Captured on a Remidio Fundus on Phone · color fundus image:
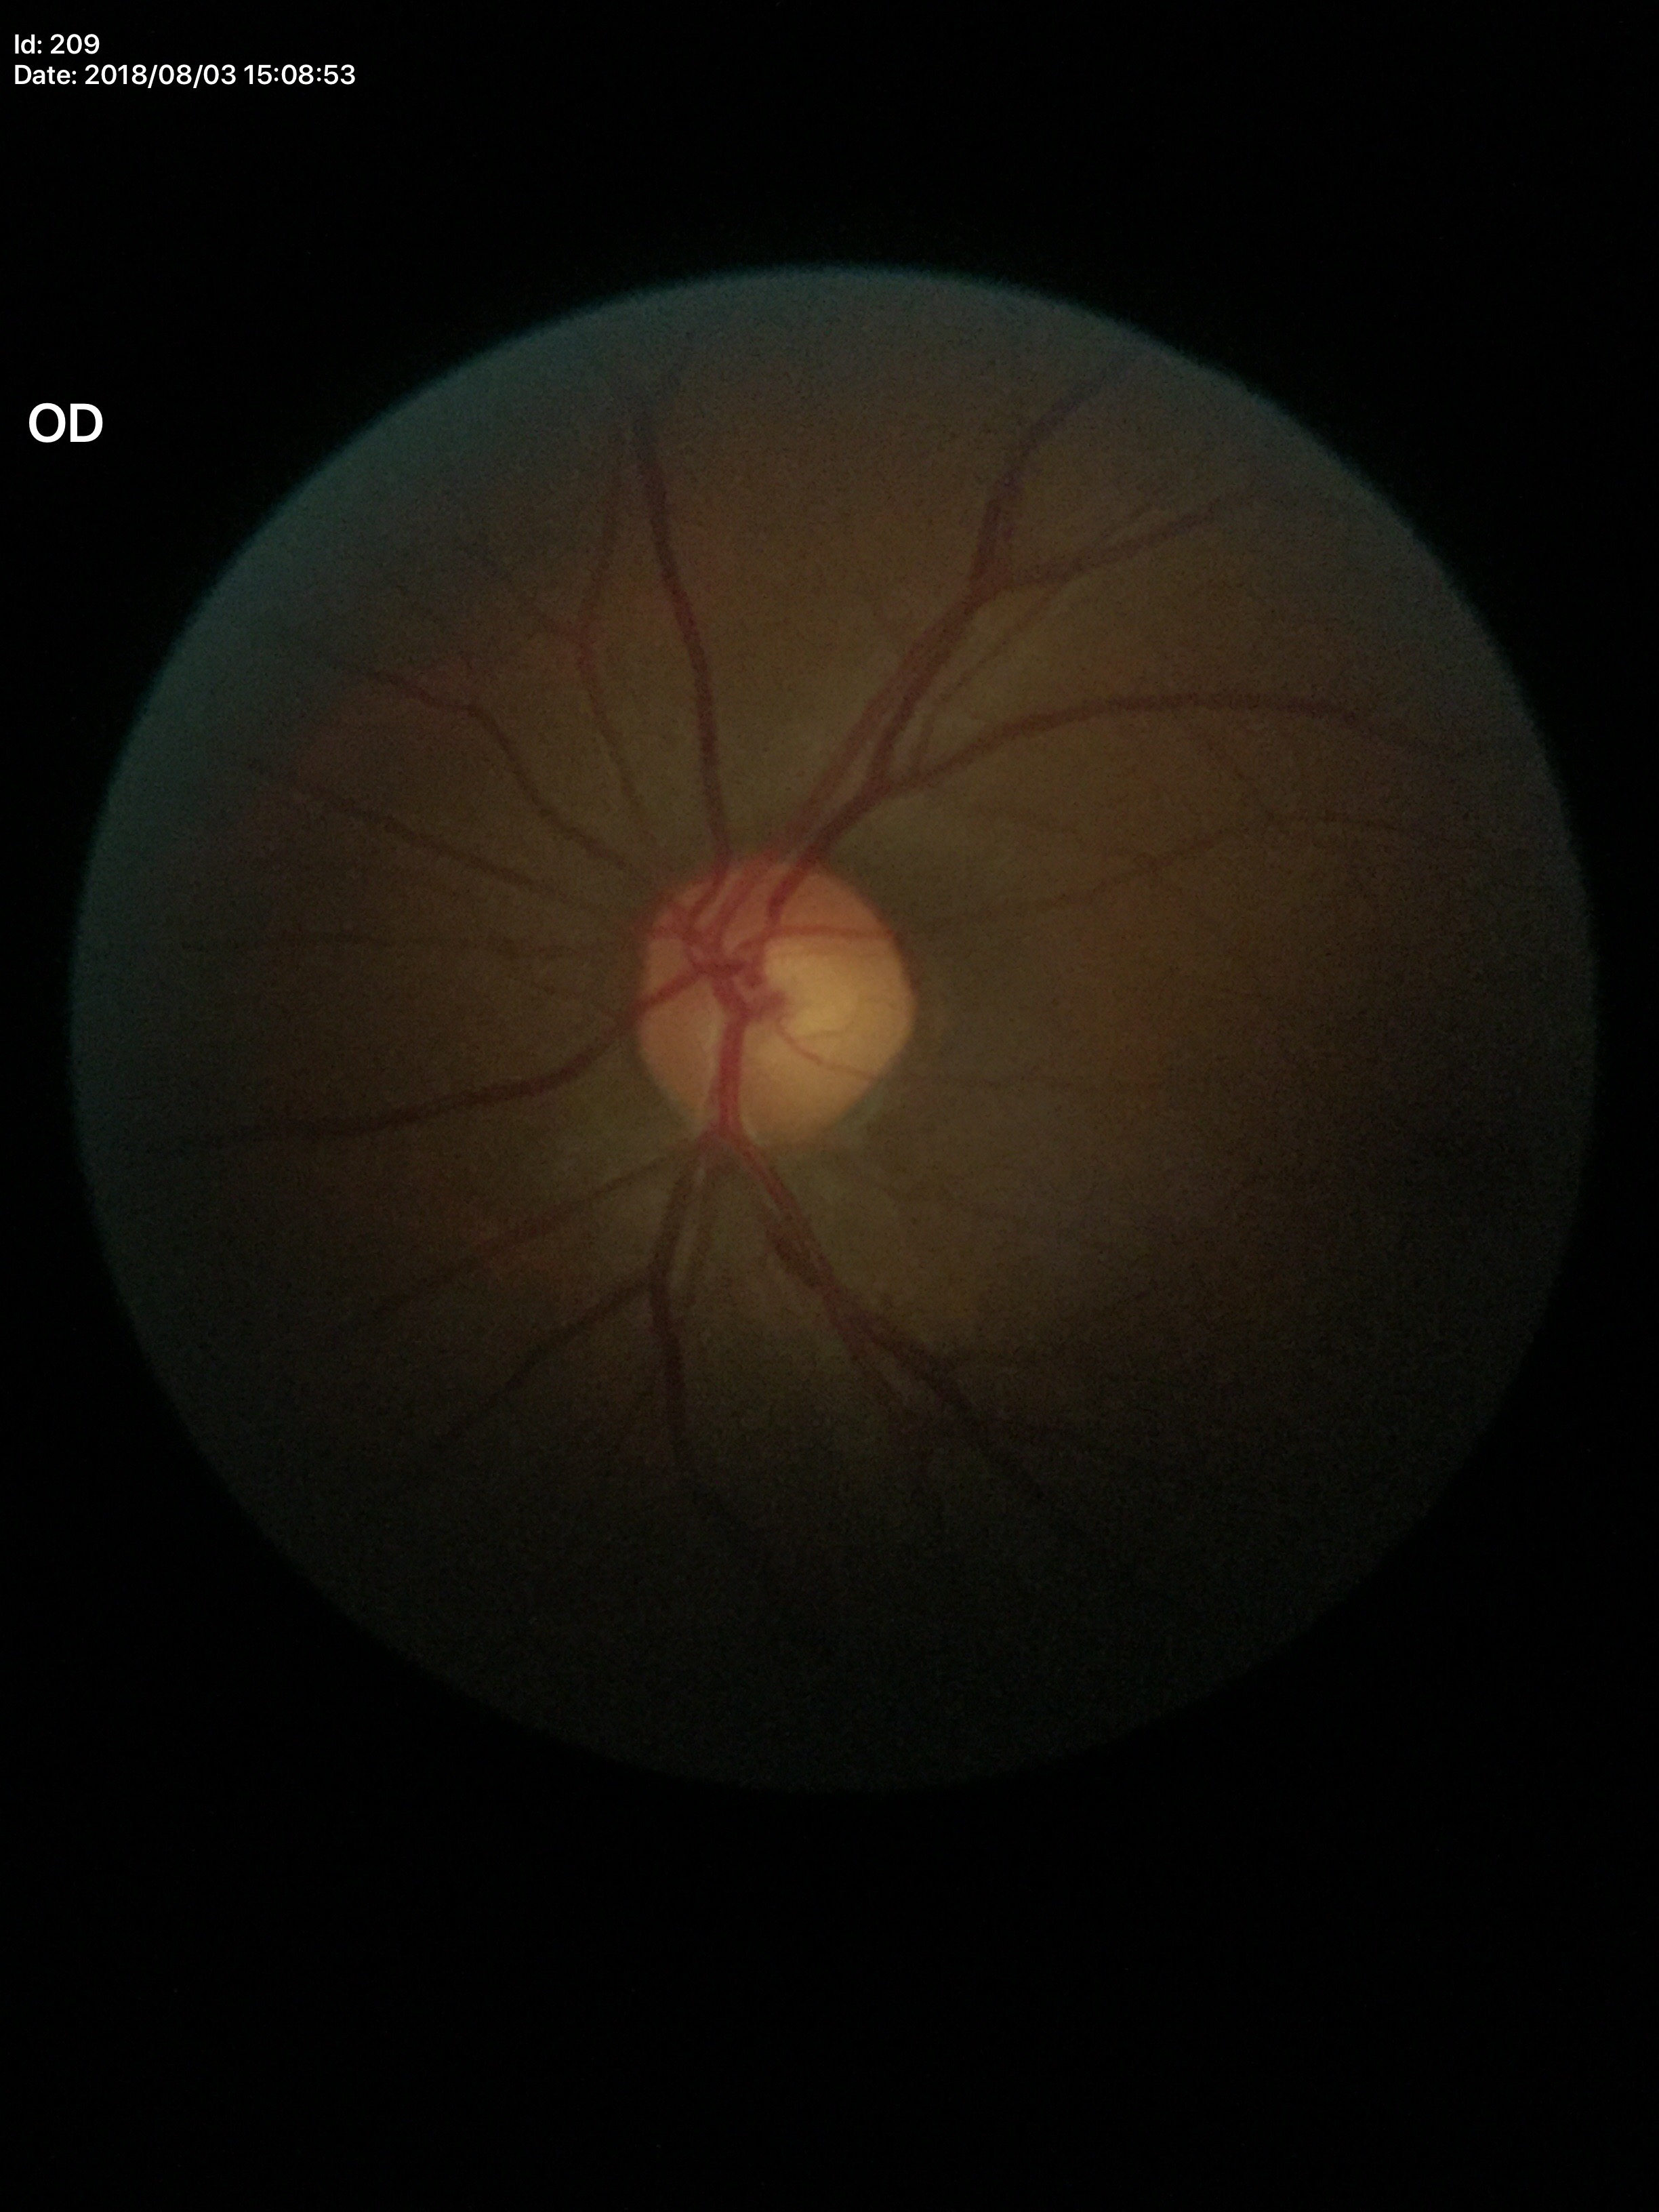

– vertical C/D ratio (VCDR) — 0.51
– Glaucoma decision — no suspicious findings